Graded on the modified Davis scale. FOV: 45 degrees:
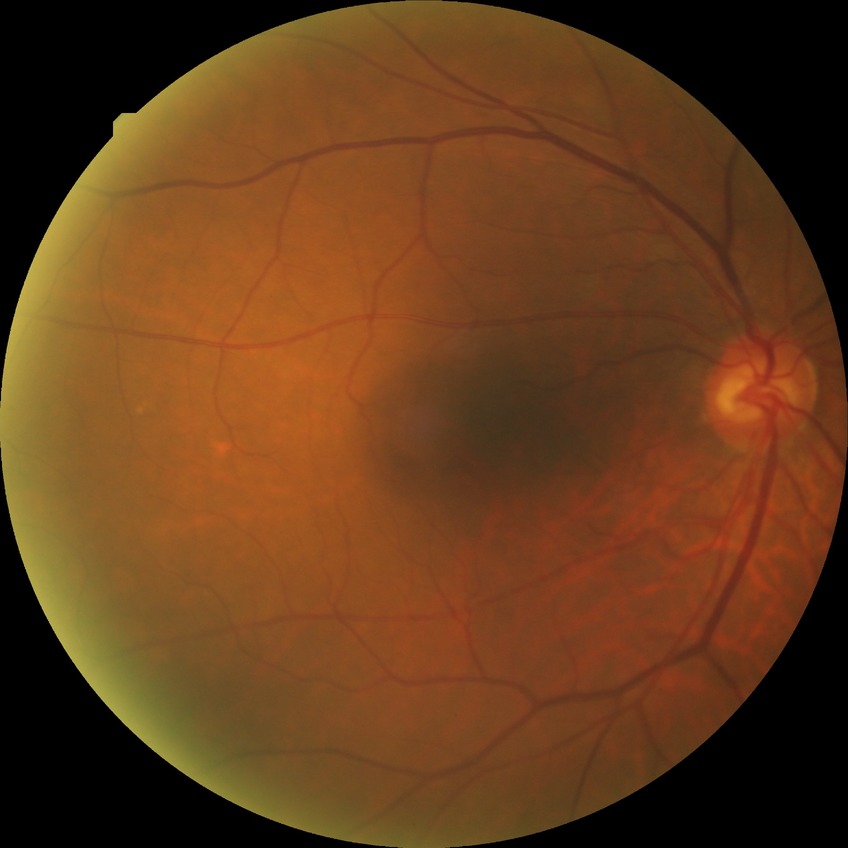 {
  "davis_grade": "NDR (no diabetic retinopathy)"
}